Posterior pole photograph · 848 by 848 pixels — 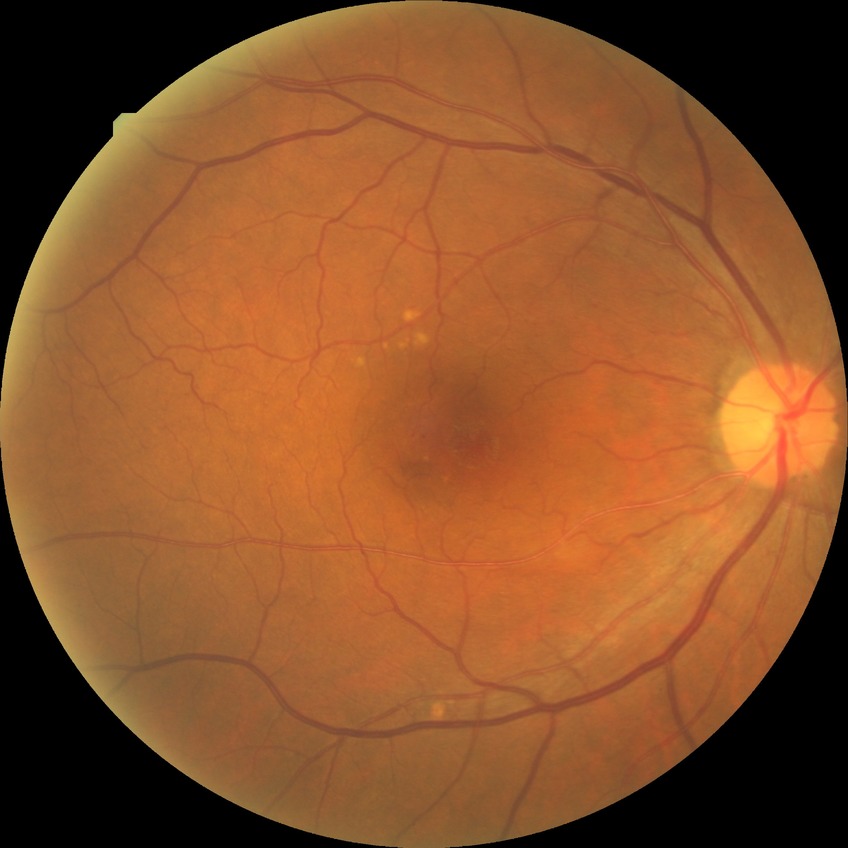 {"davis_grade": "NDR (no diabetic retinopathy)"}